Image size 2352x1568.
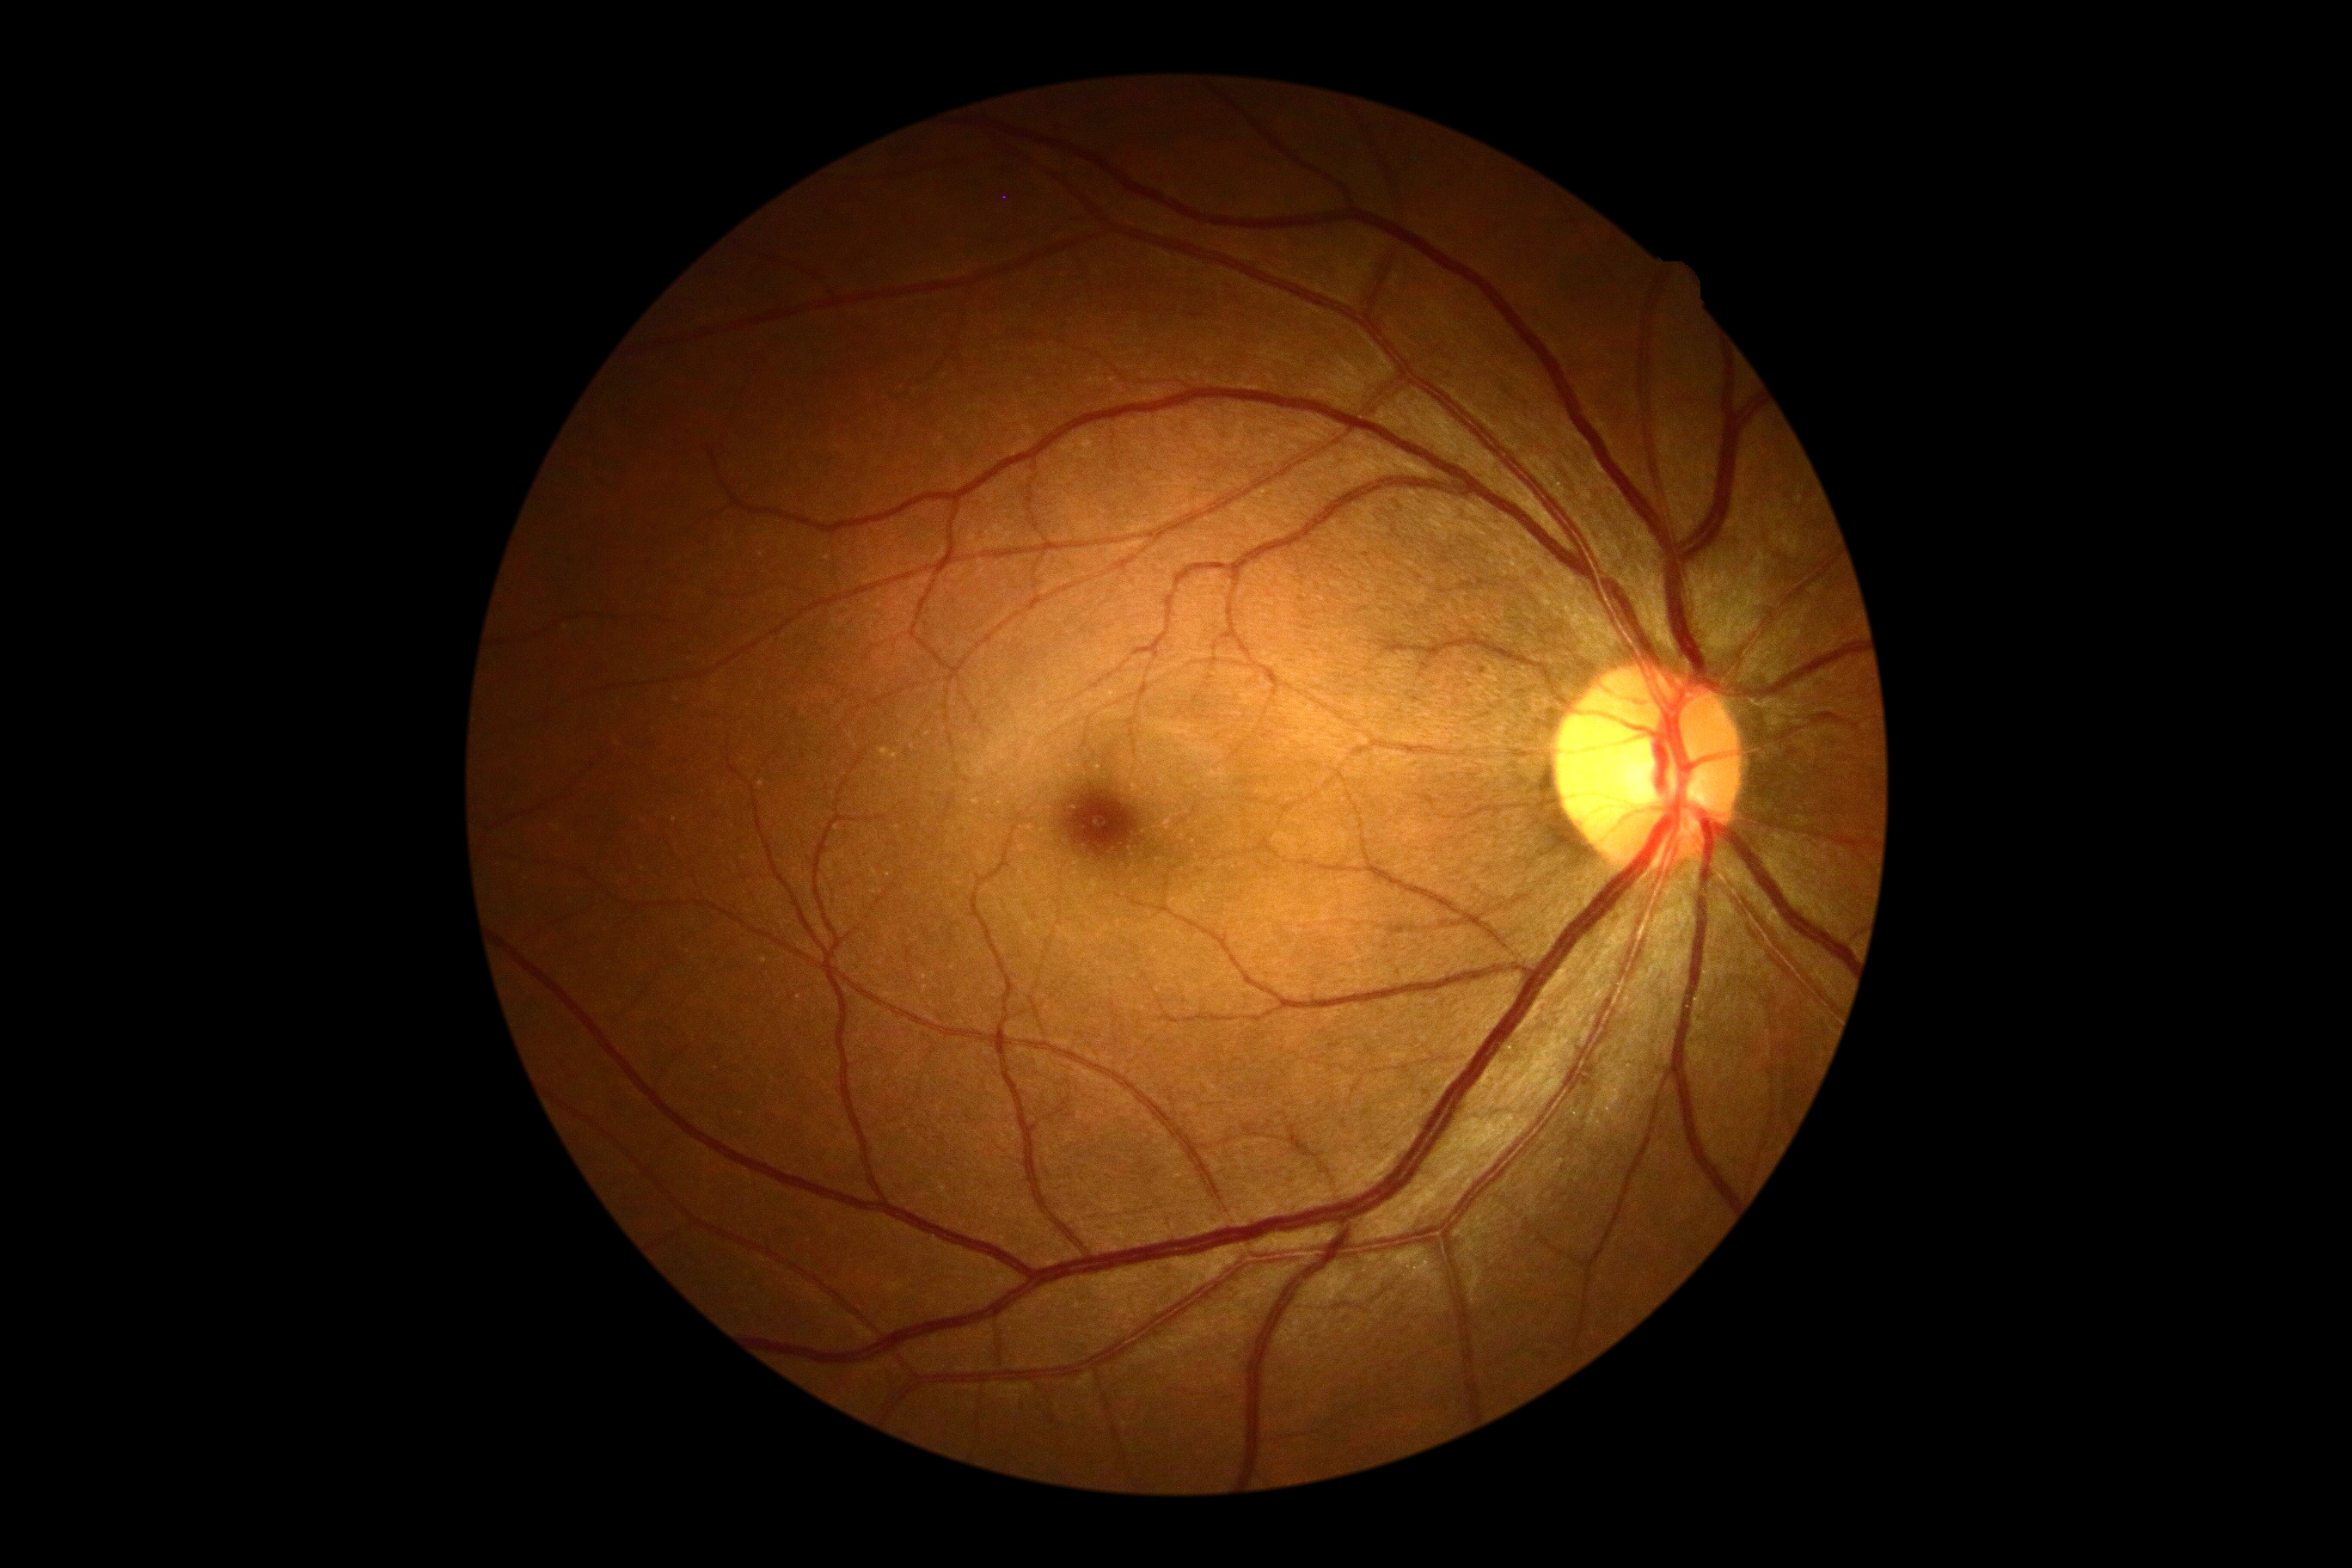
diabetic retinopathy severity = grade 0 (no apparent retinopathy).